CFP
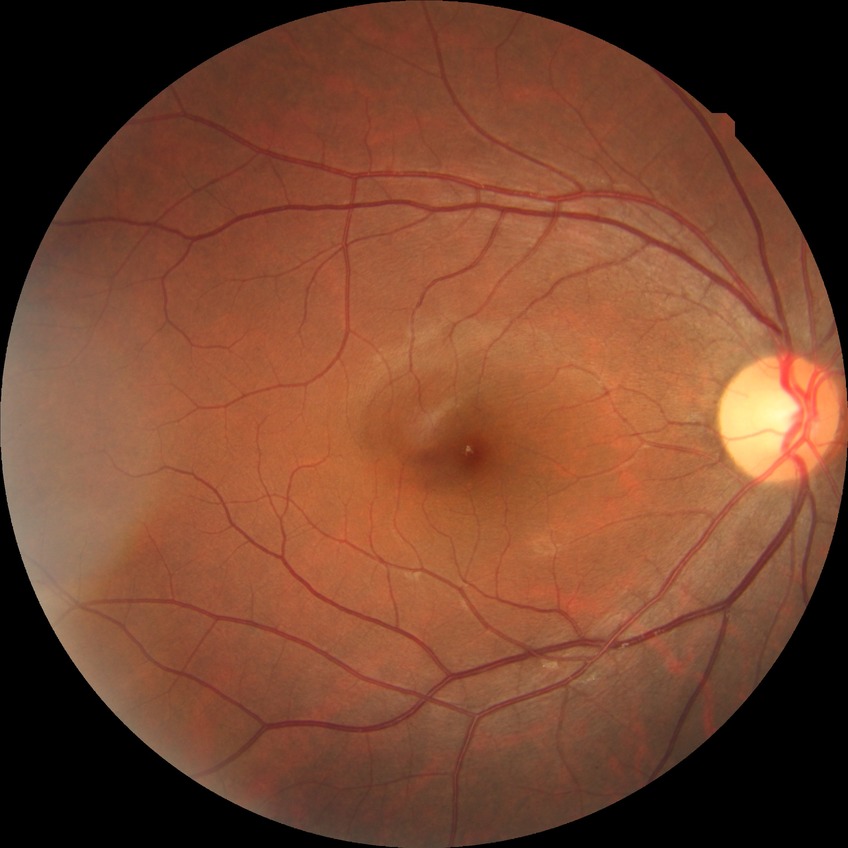

Diabetic retinopathy grade is no diabetic retinopathy.